45° FOV. Image size 2352x1568. Color fundus image.
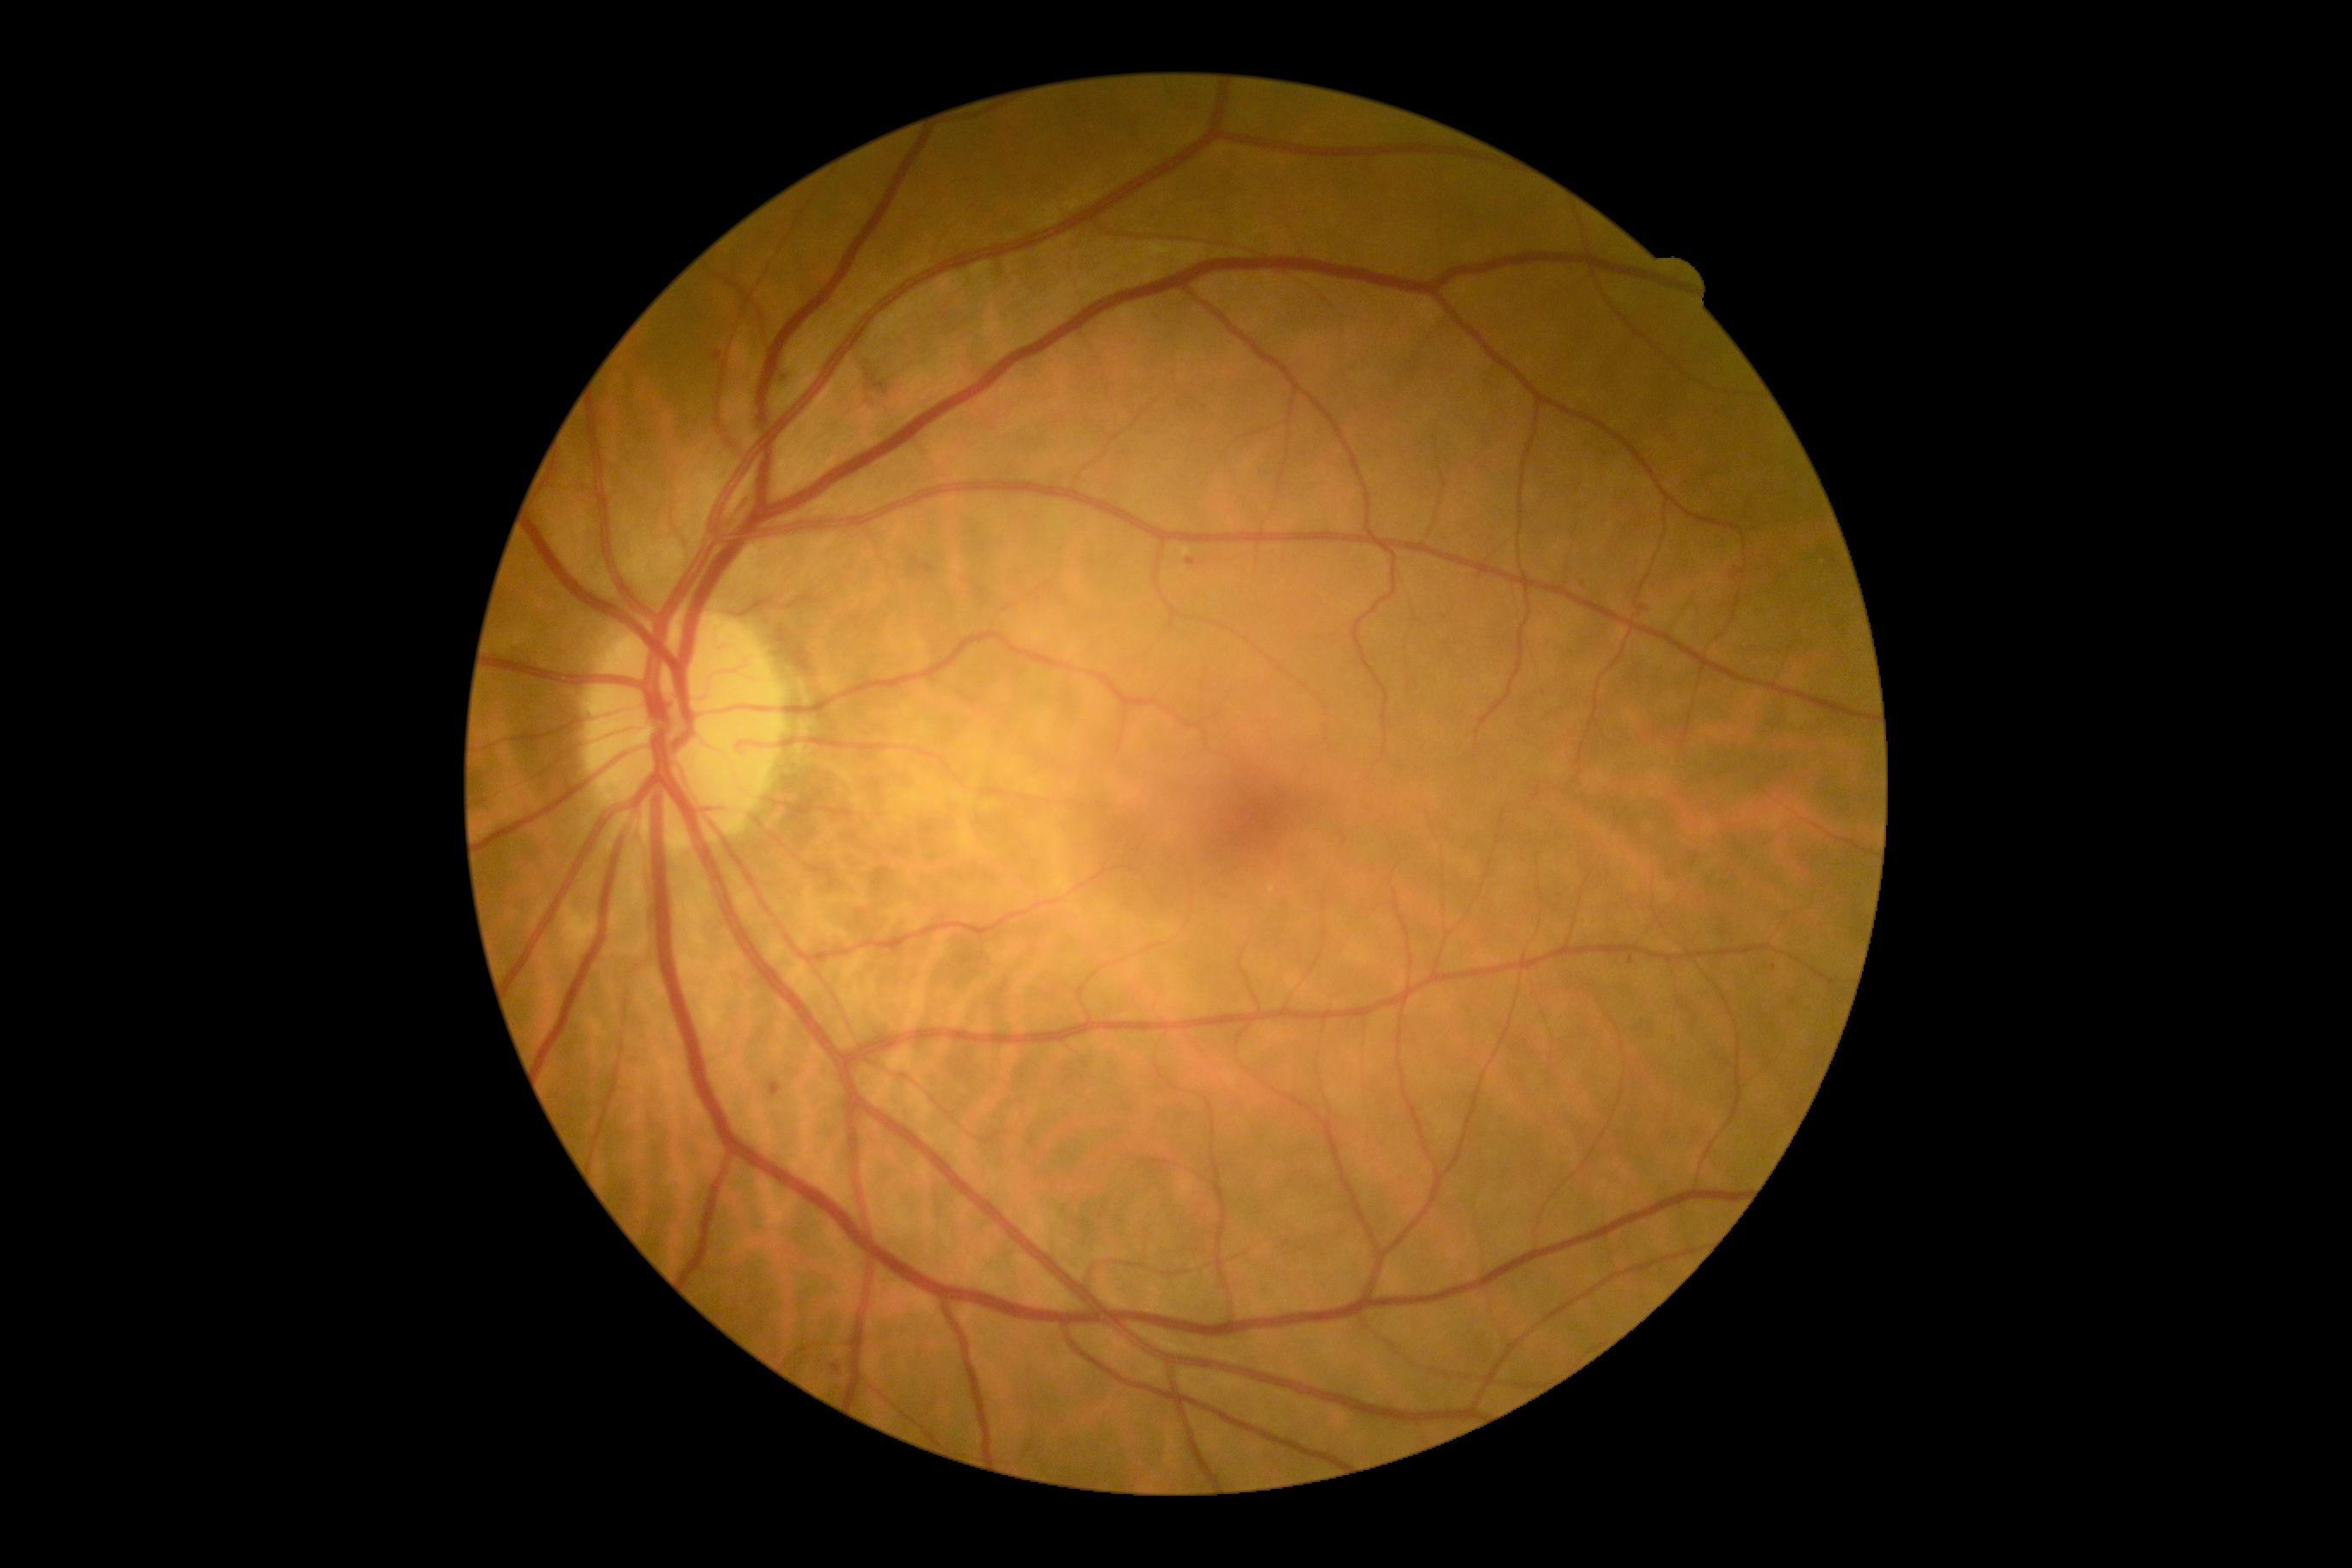
DR severity: 2.